Wide-field contact fundus photograph of an infant · image size 1240x1240
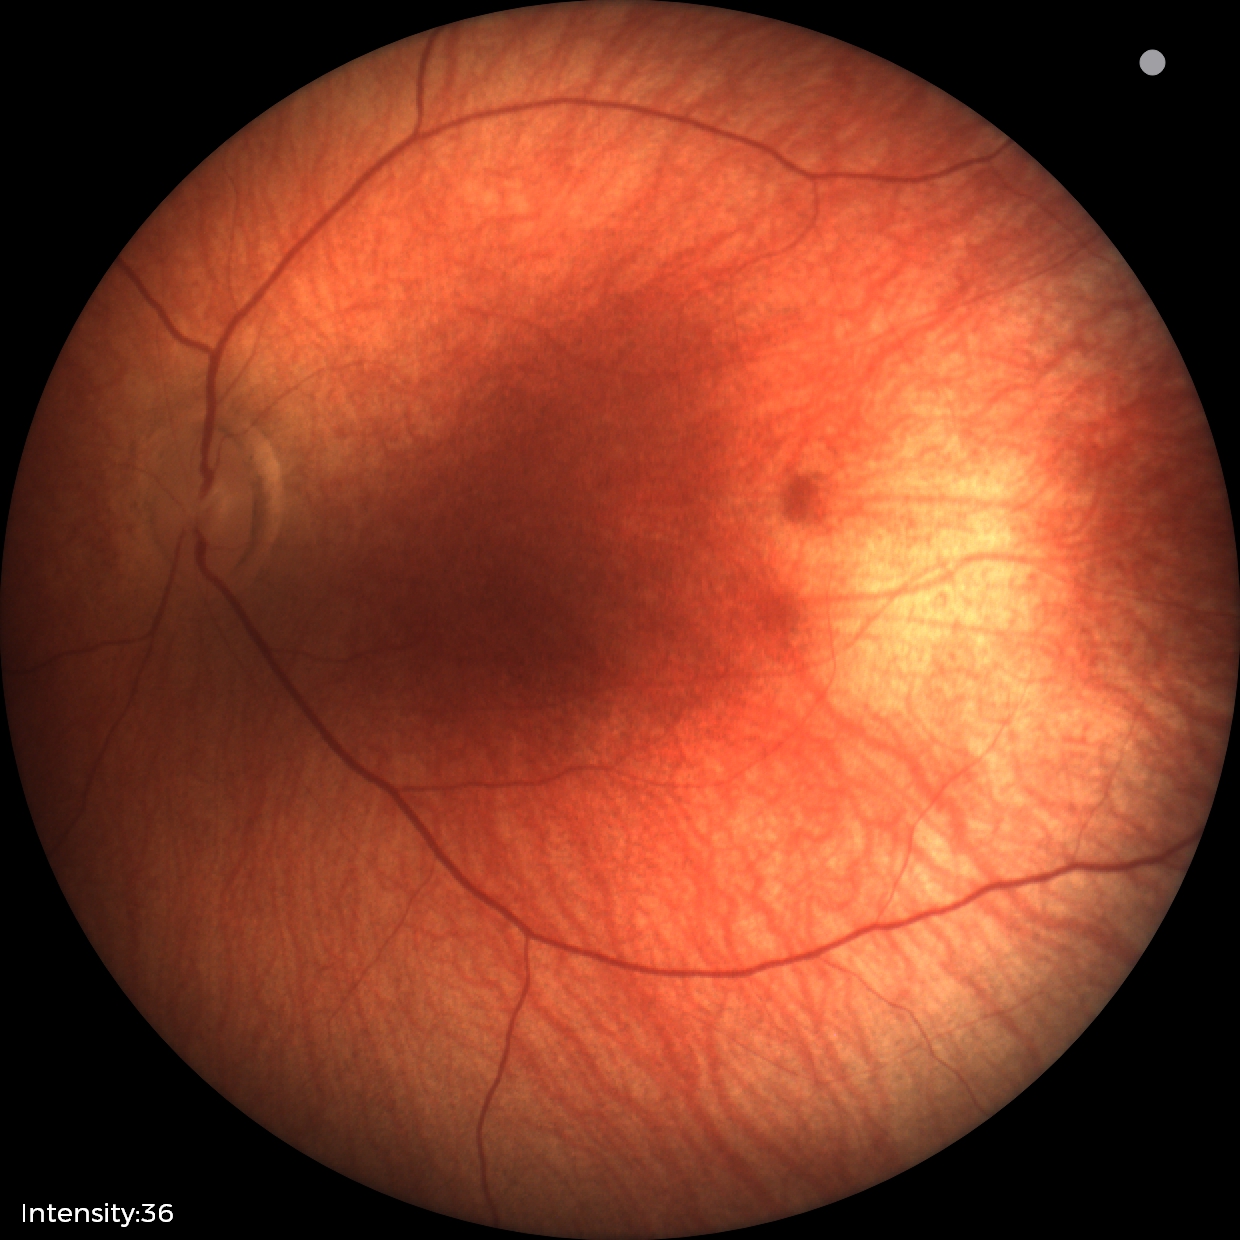 Examination with physiological retinal findings.